Image size 2212x1659 — 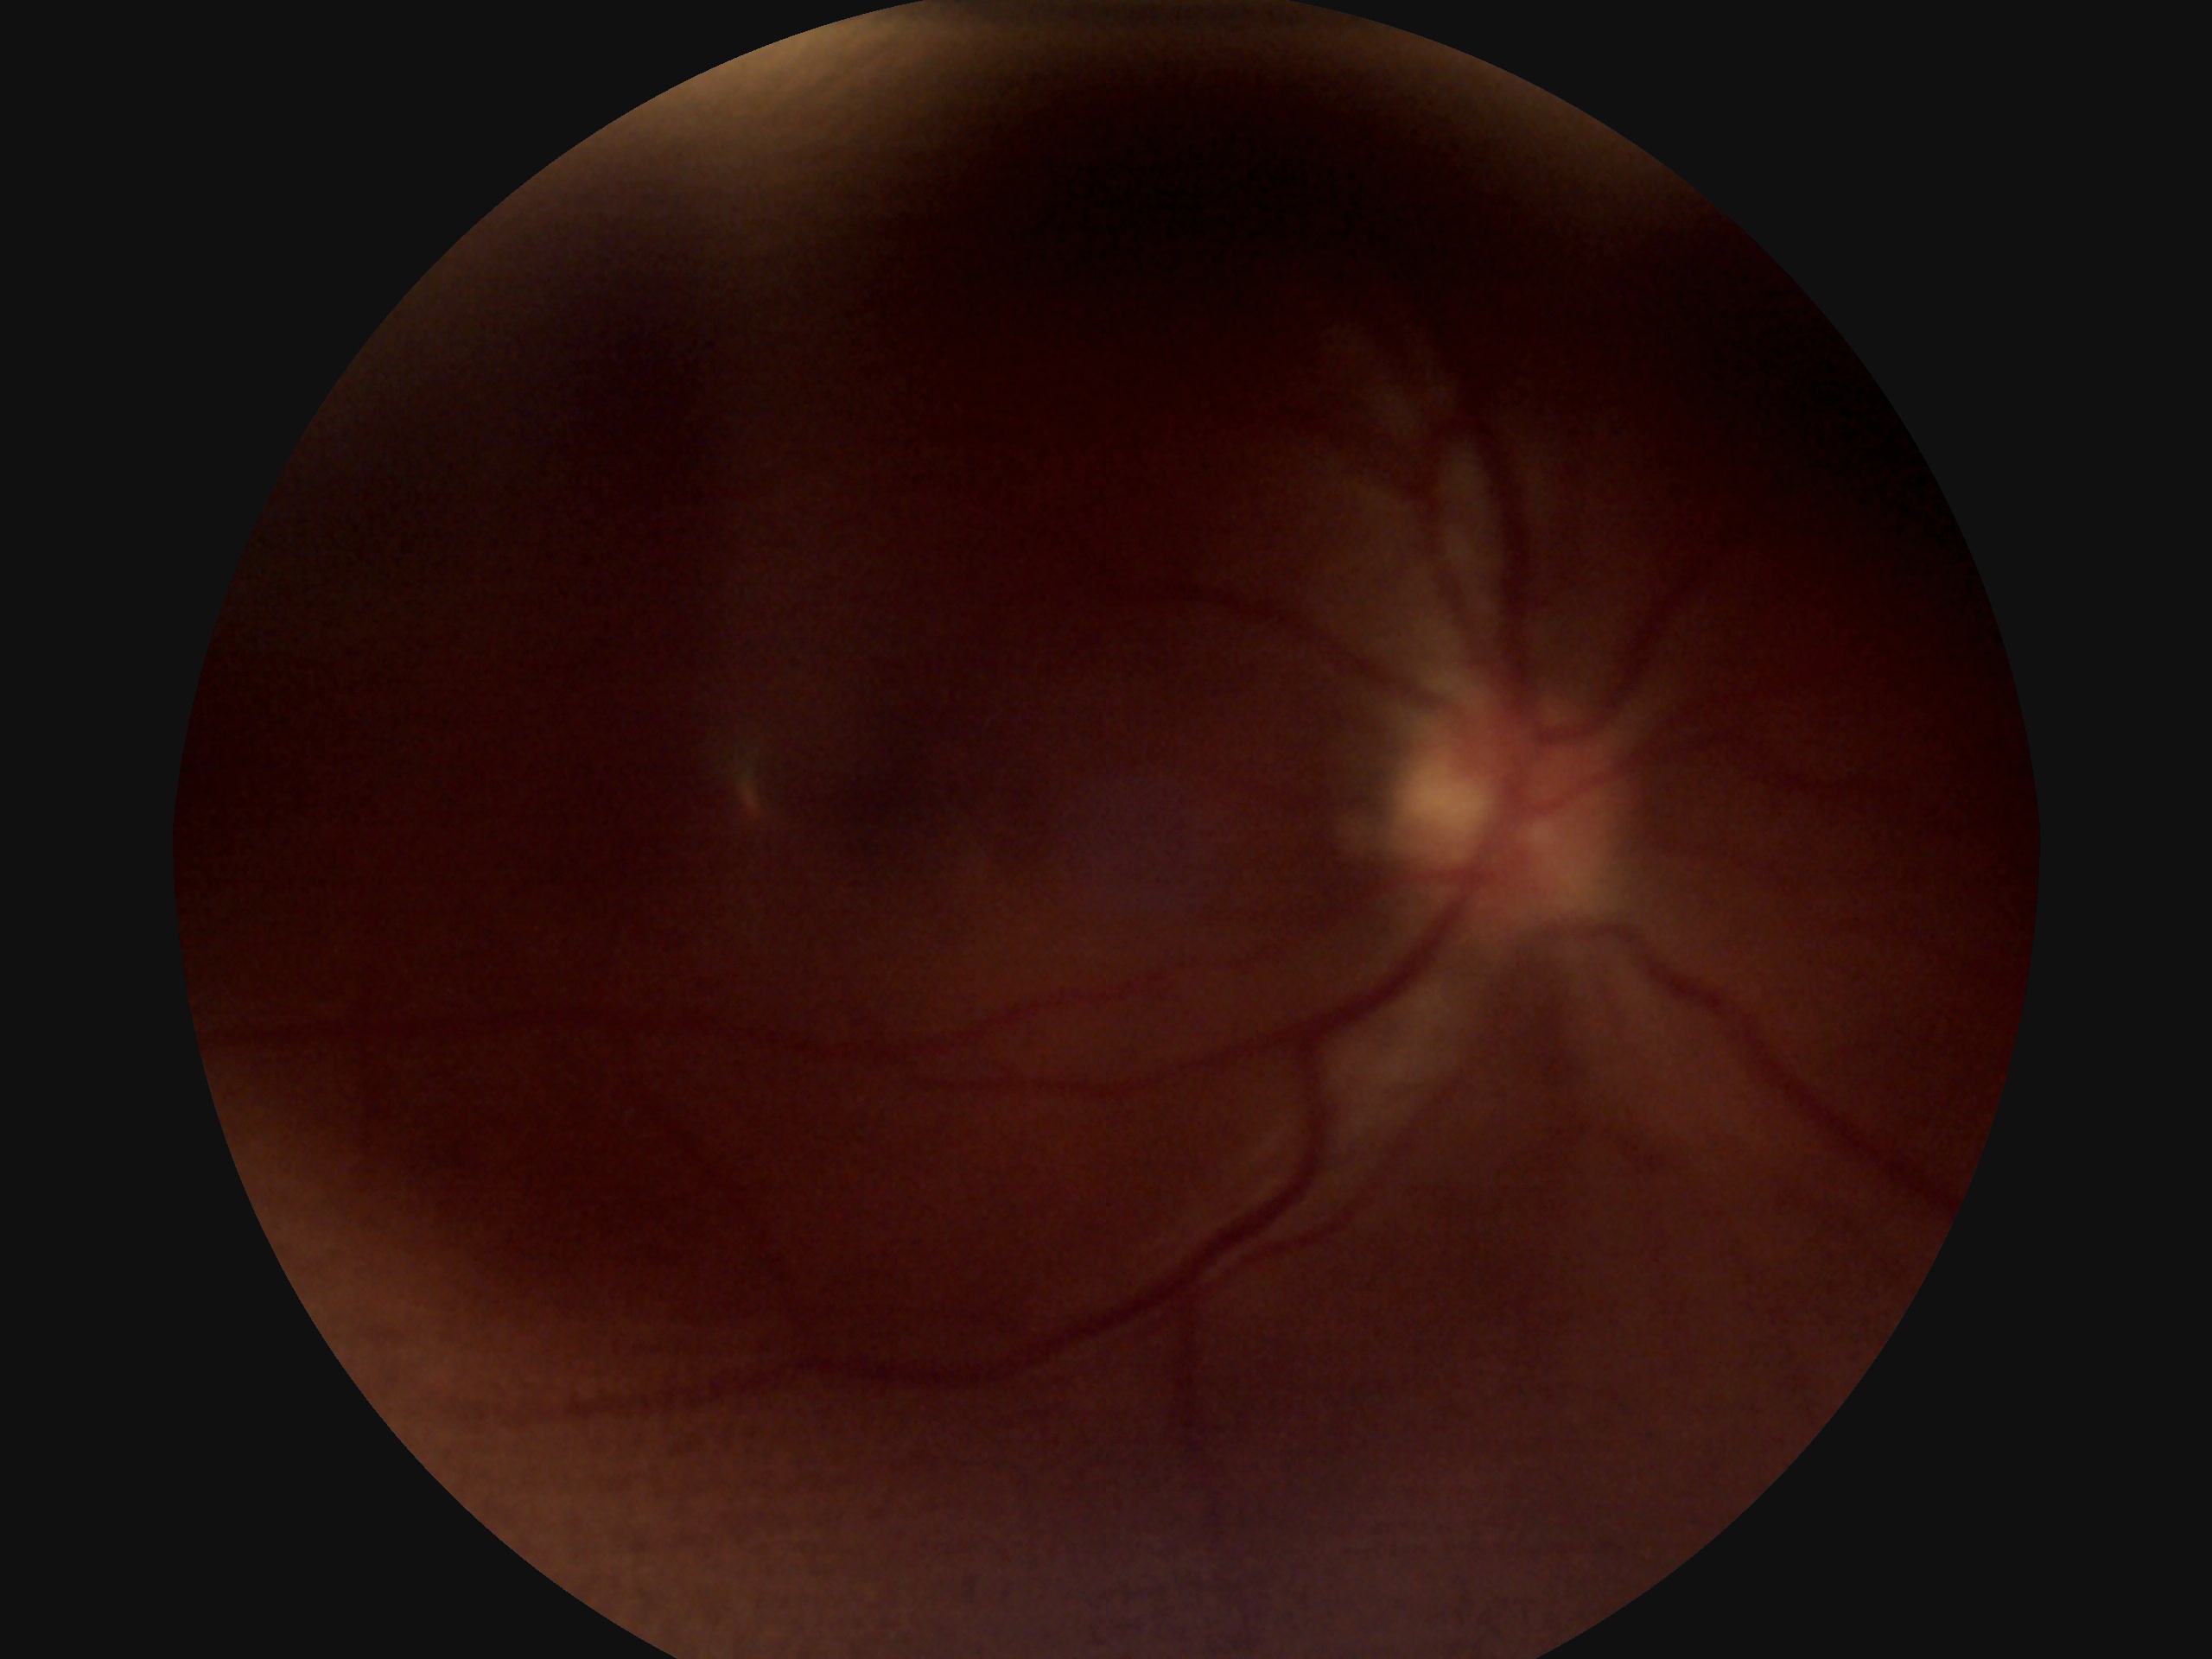

Diabetic retinopathy (DR) is 0.